No pharmacologic dilation — 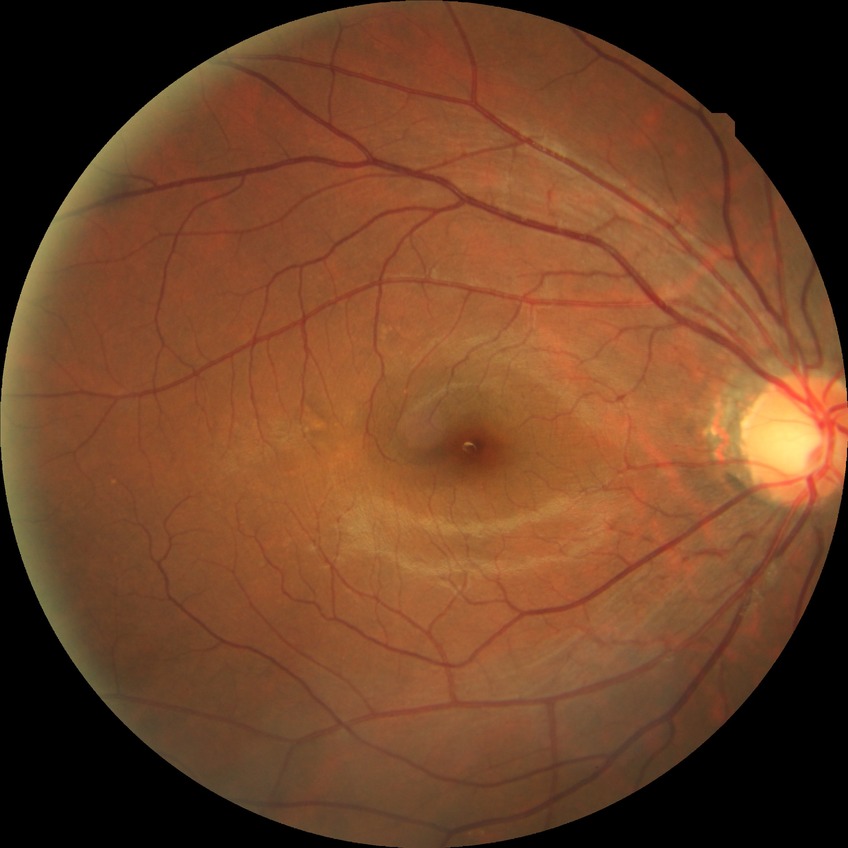 diabetic retinopathy (DR)@NDR (no diabetic retinopathy).